CFP. Captured on a Bosch fundus camera. 1920x1440px:
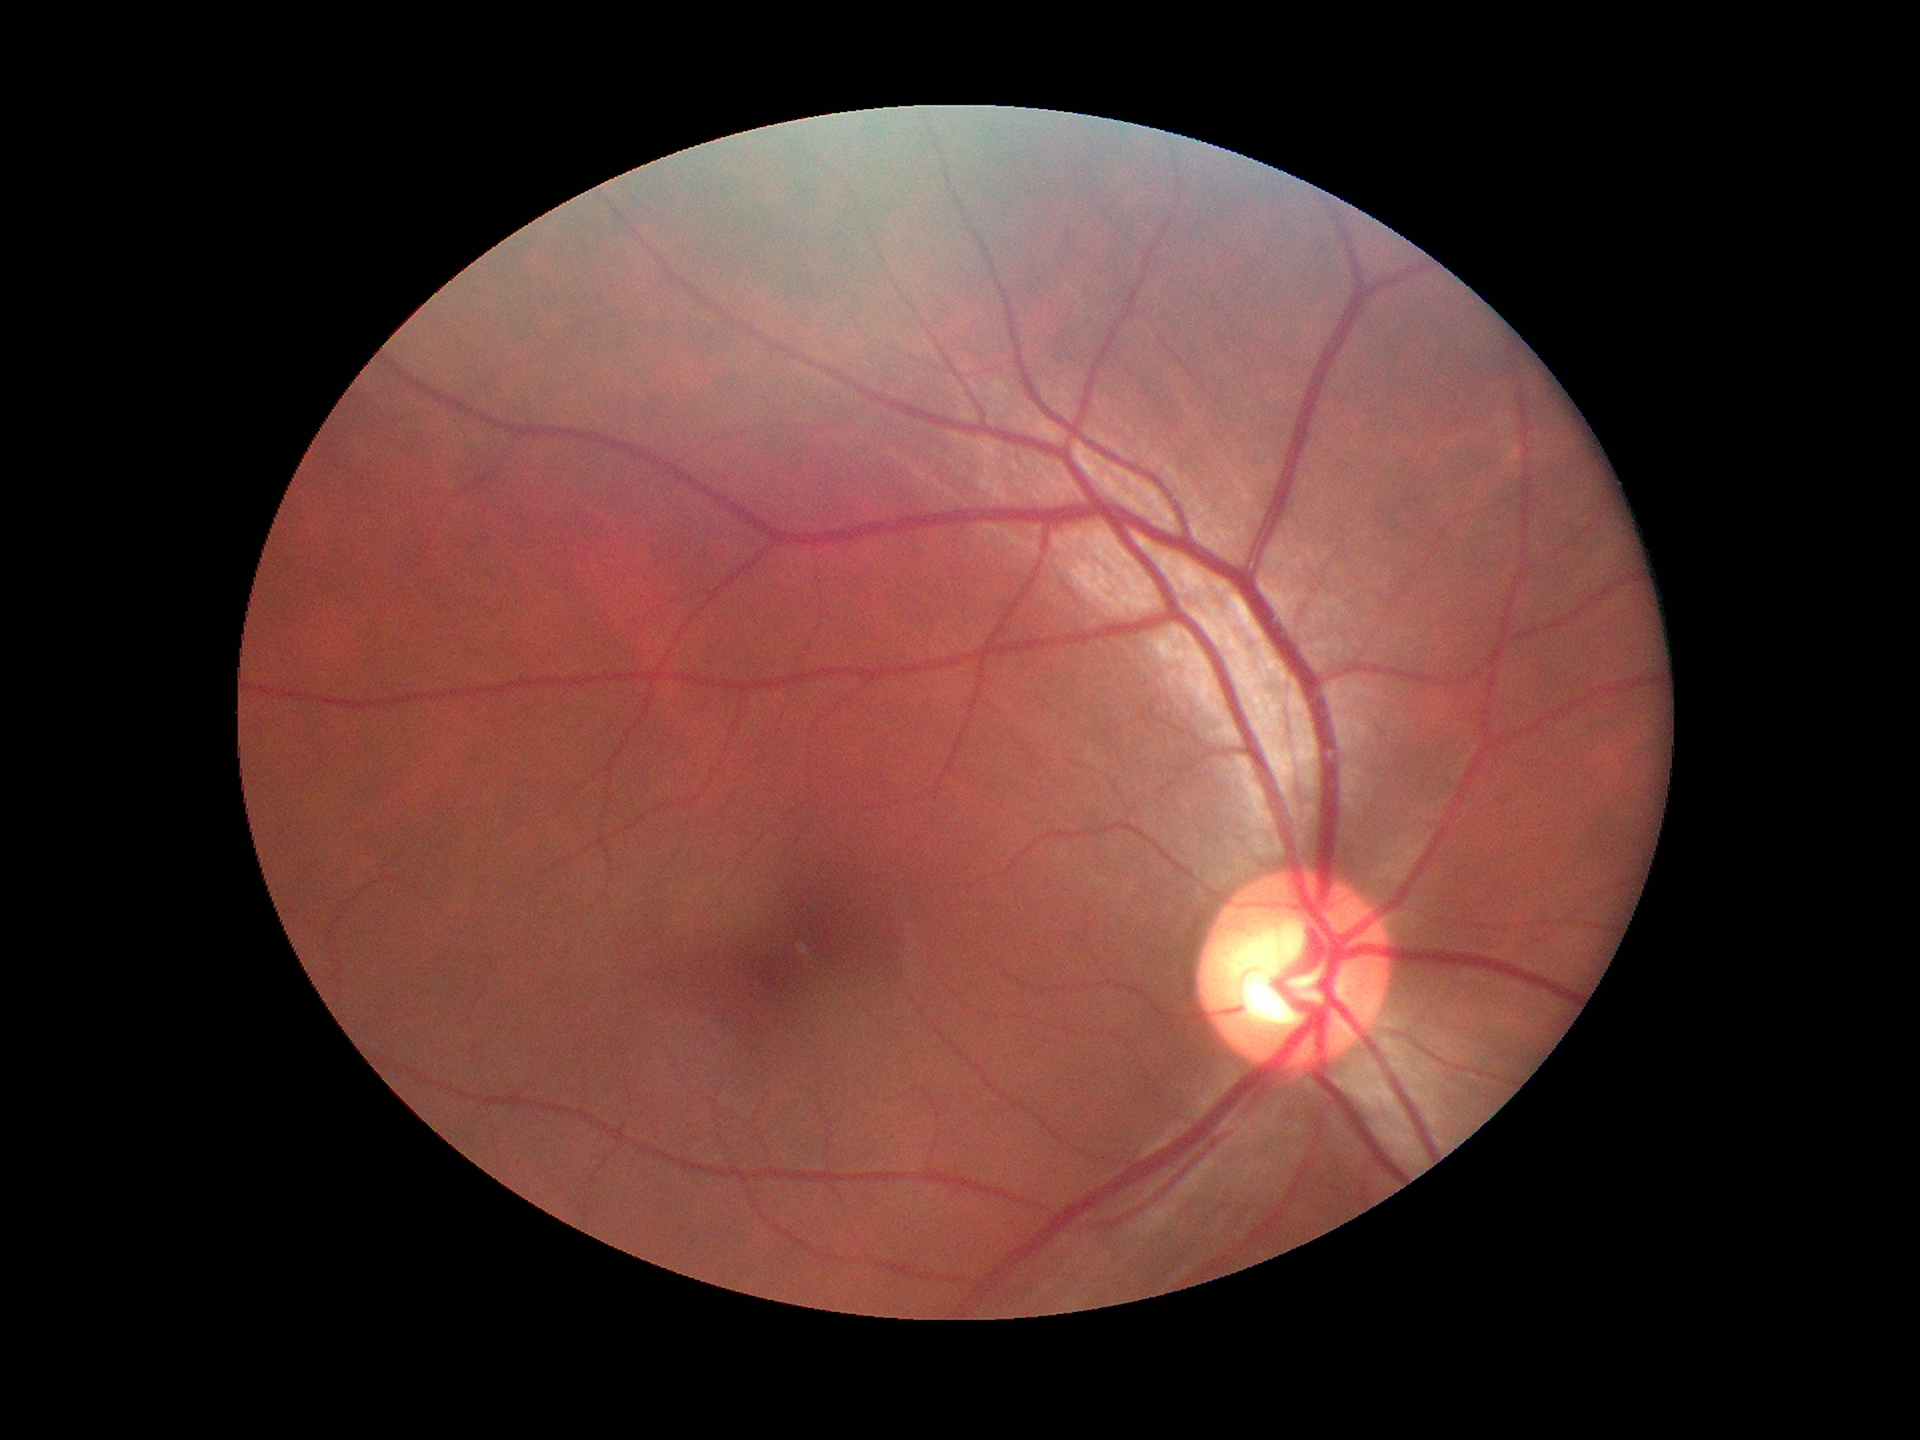

{"vcdr": "0.58", "glaucoma_decision": "negative"}